CFP:
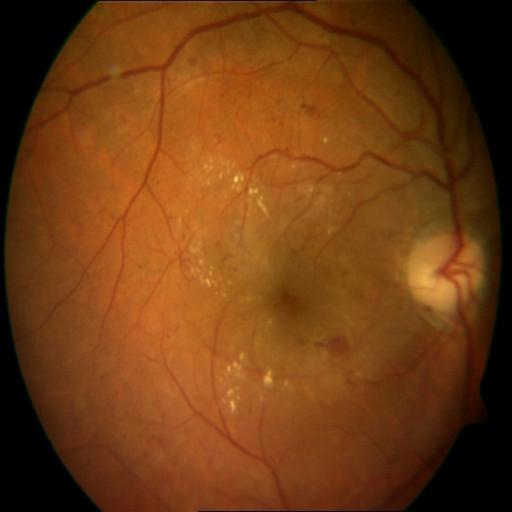
Diagnosis: HR (hemorrhagic retinopathy).